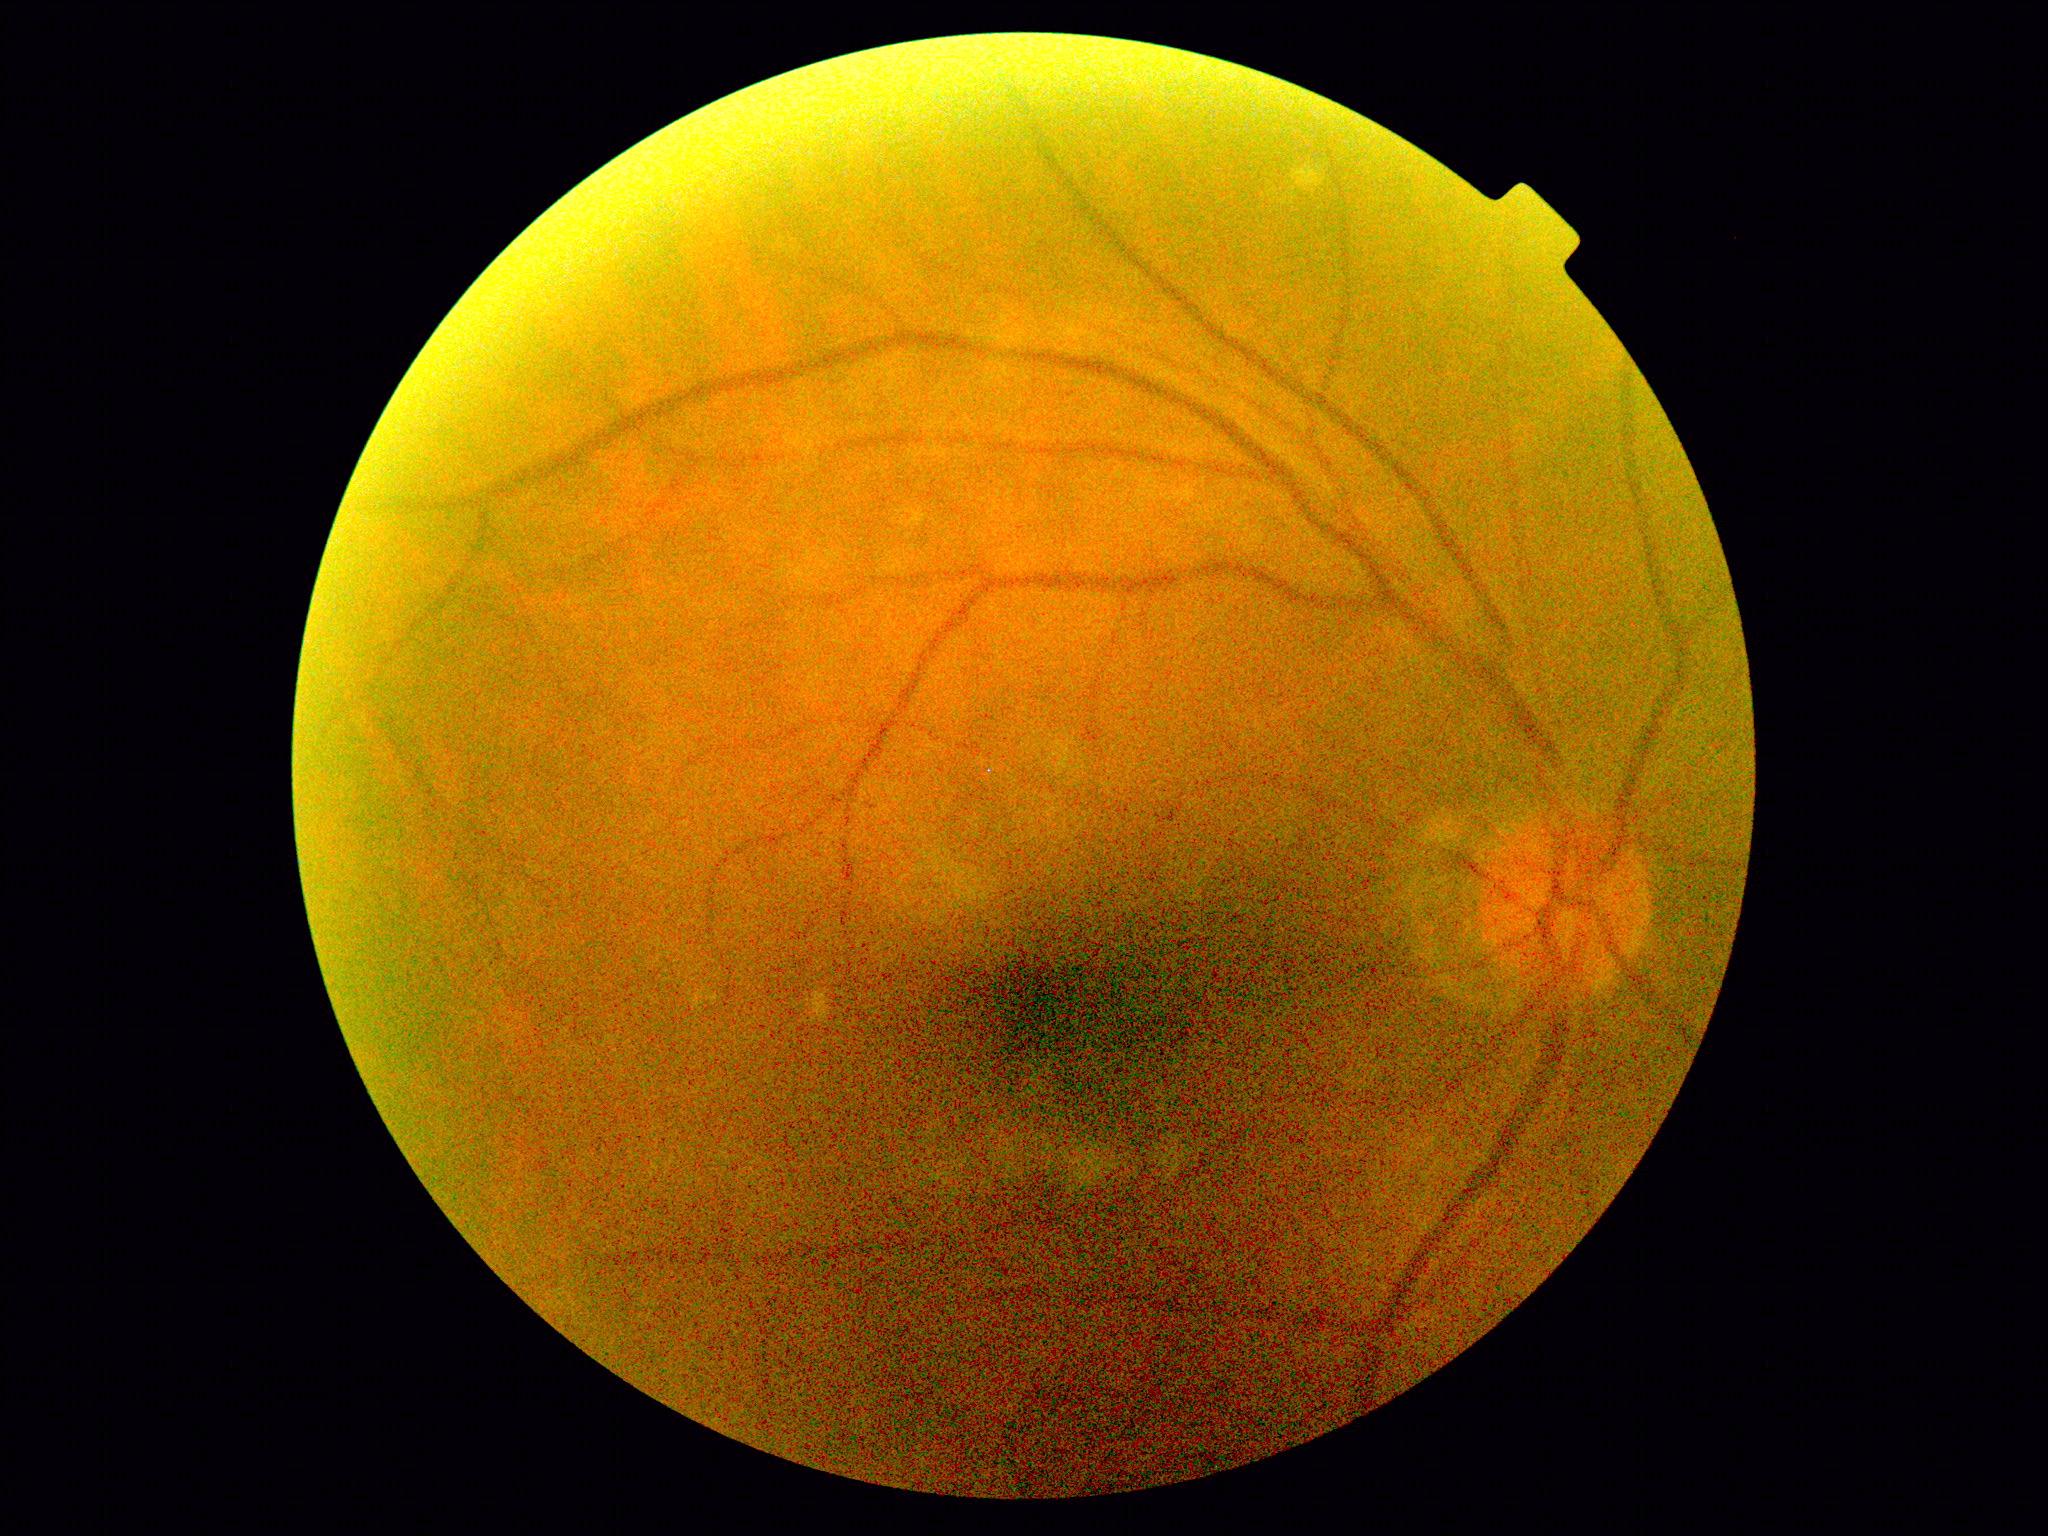

Diabetic retinopathy (DR): no apparent retinopathy (grade 0).
No signs of diabetic retinopathy.